848x848px · modified Davis classification:
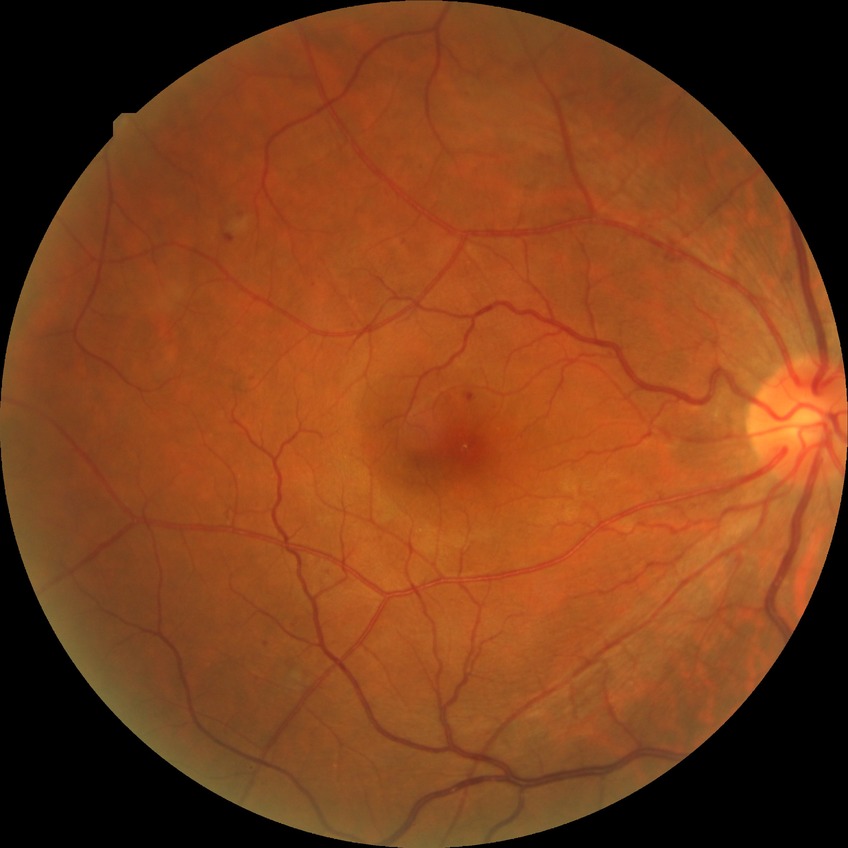
diabetic retinopathy (DR): SDR (simple diabetic retinopathy); DR class: non-proliferative diabetic retinopathy.